2352x1568; 45-degree field of view; retinal fundus photograph: 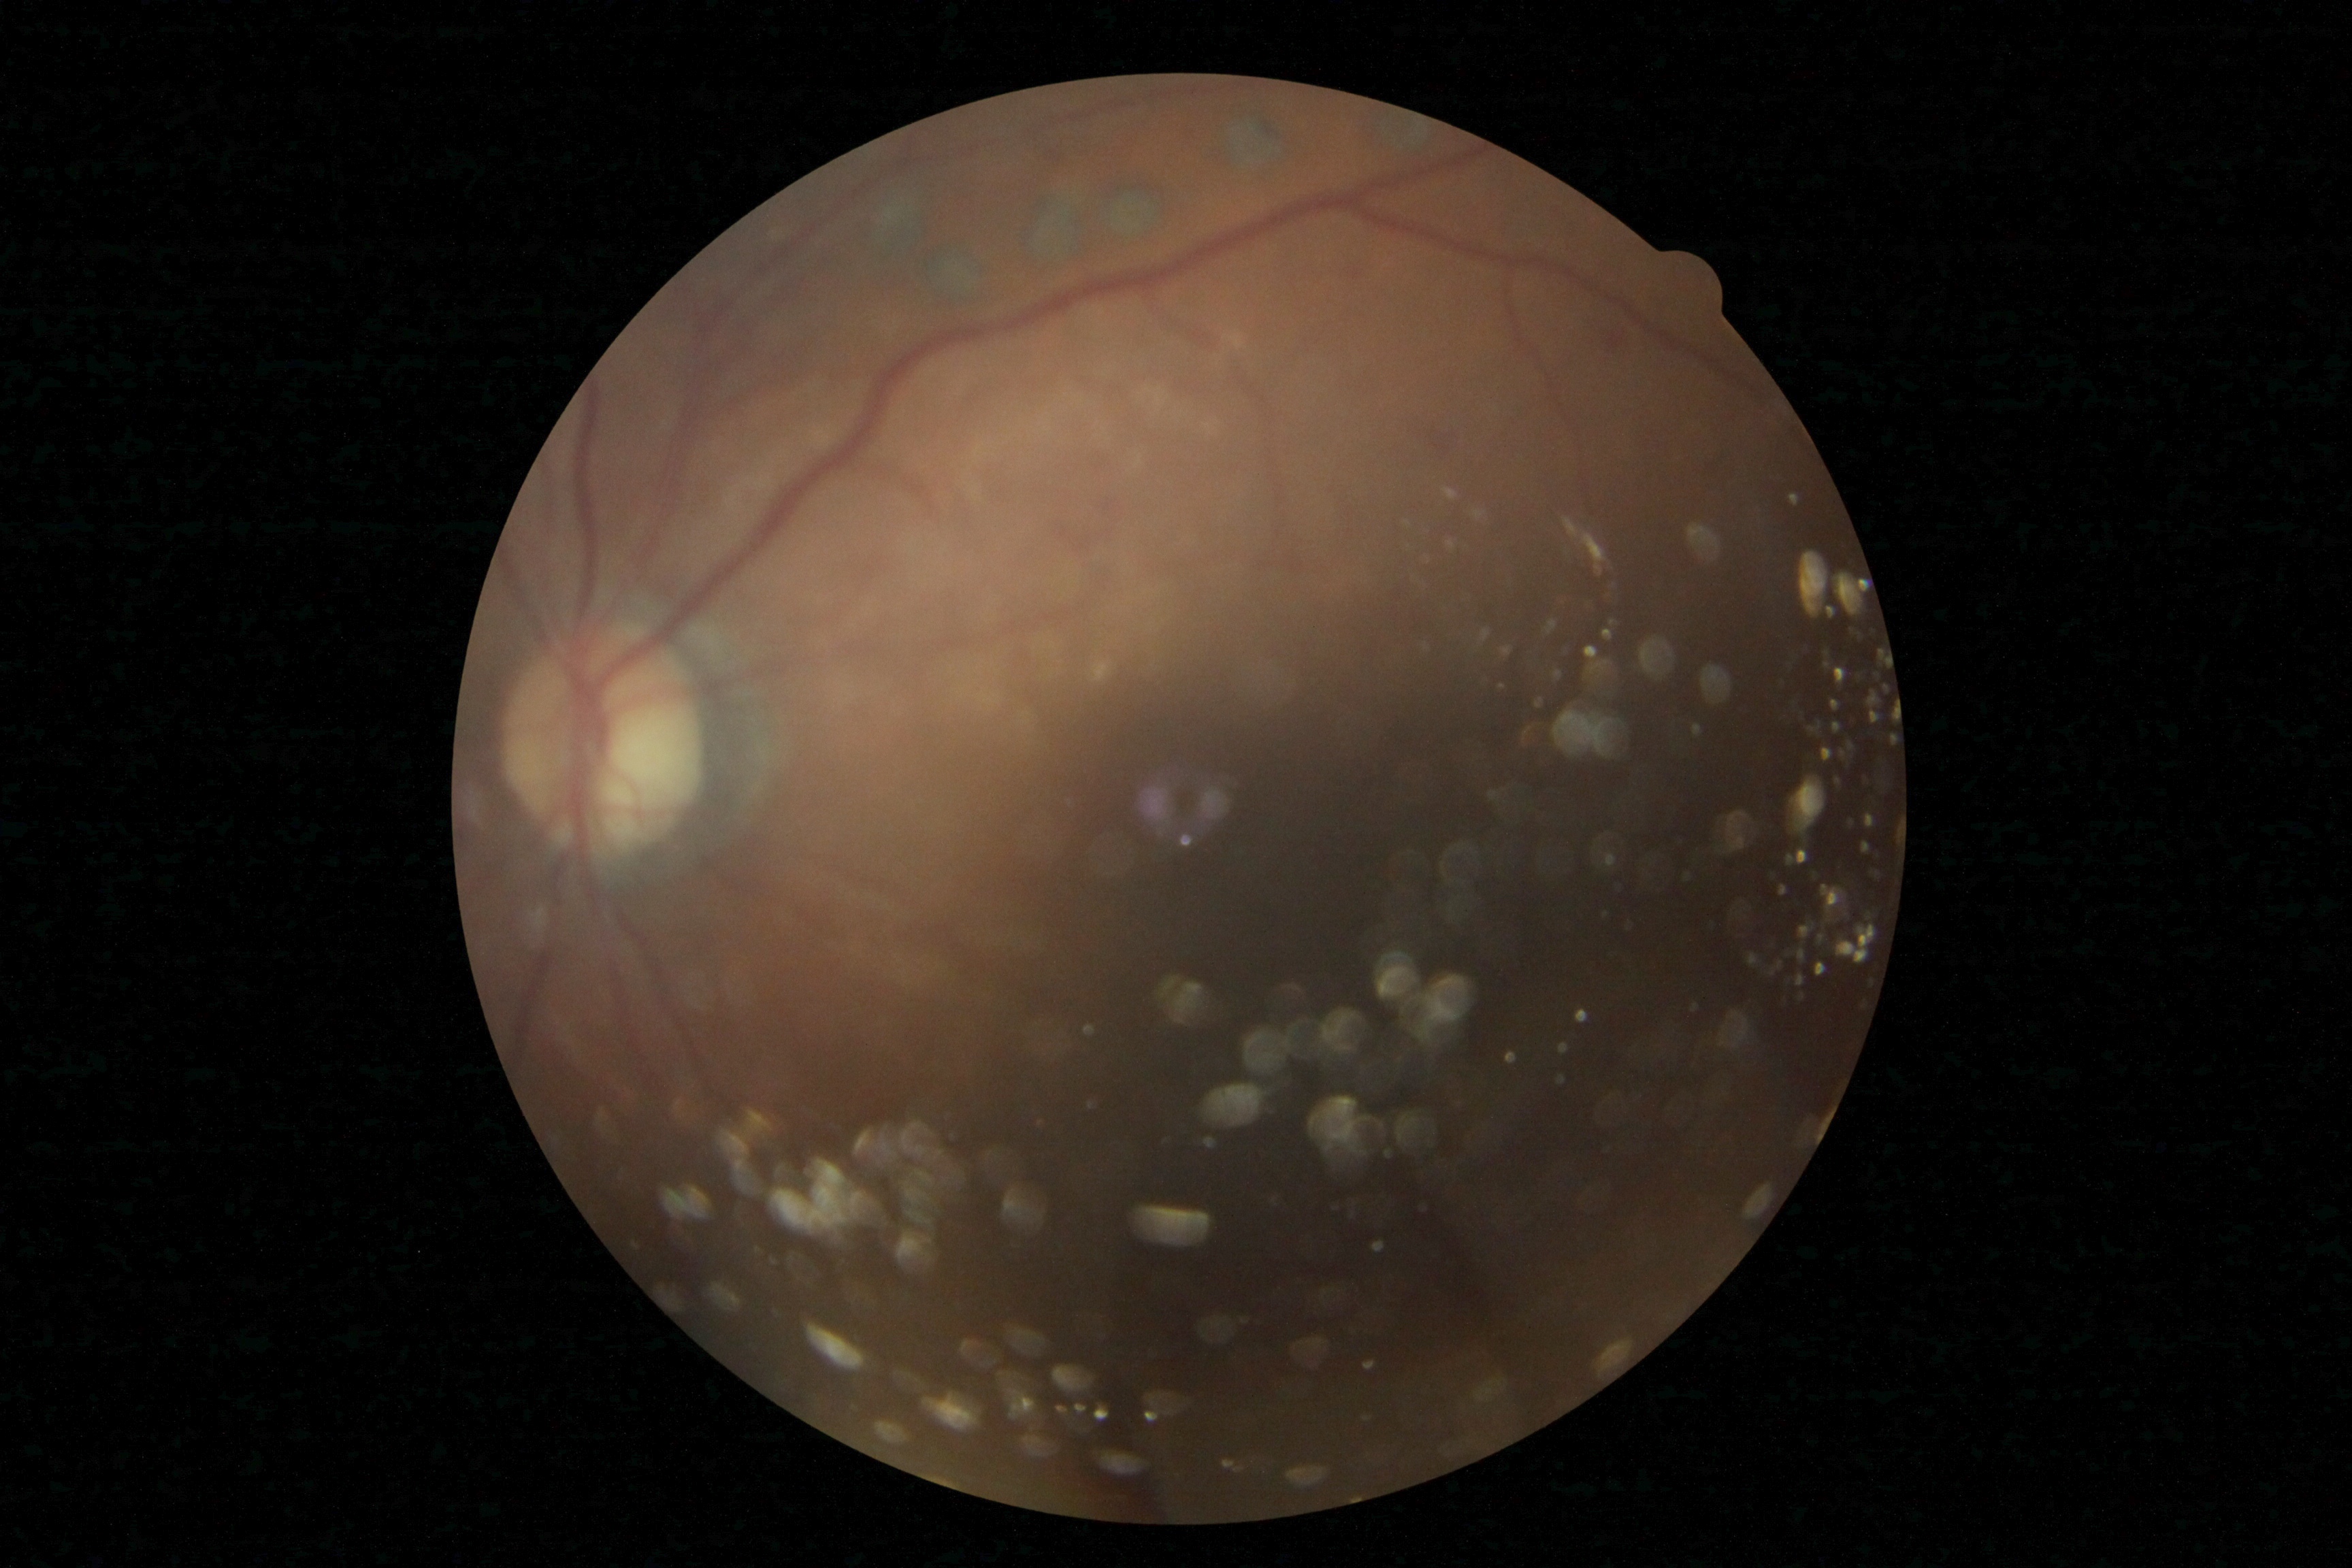 DR: moderate non-proliferative diabetic retinopathy (grade 2).